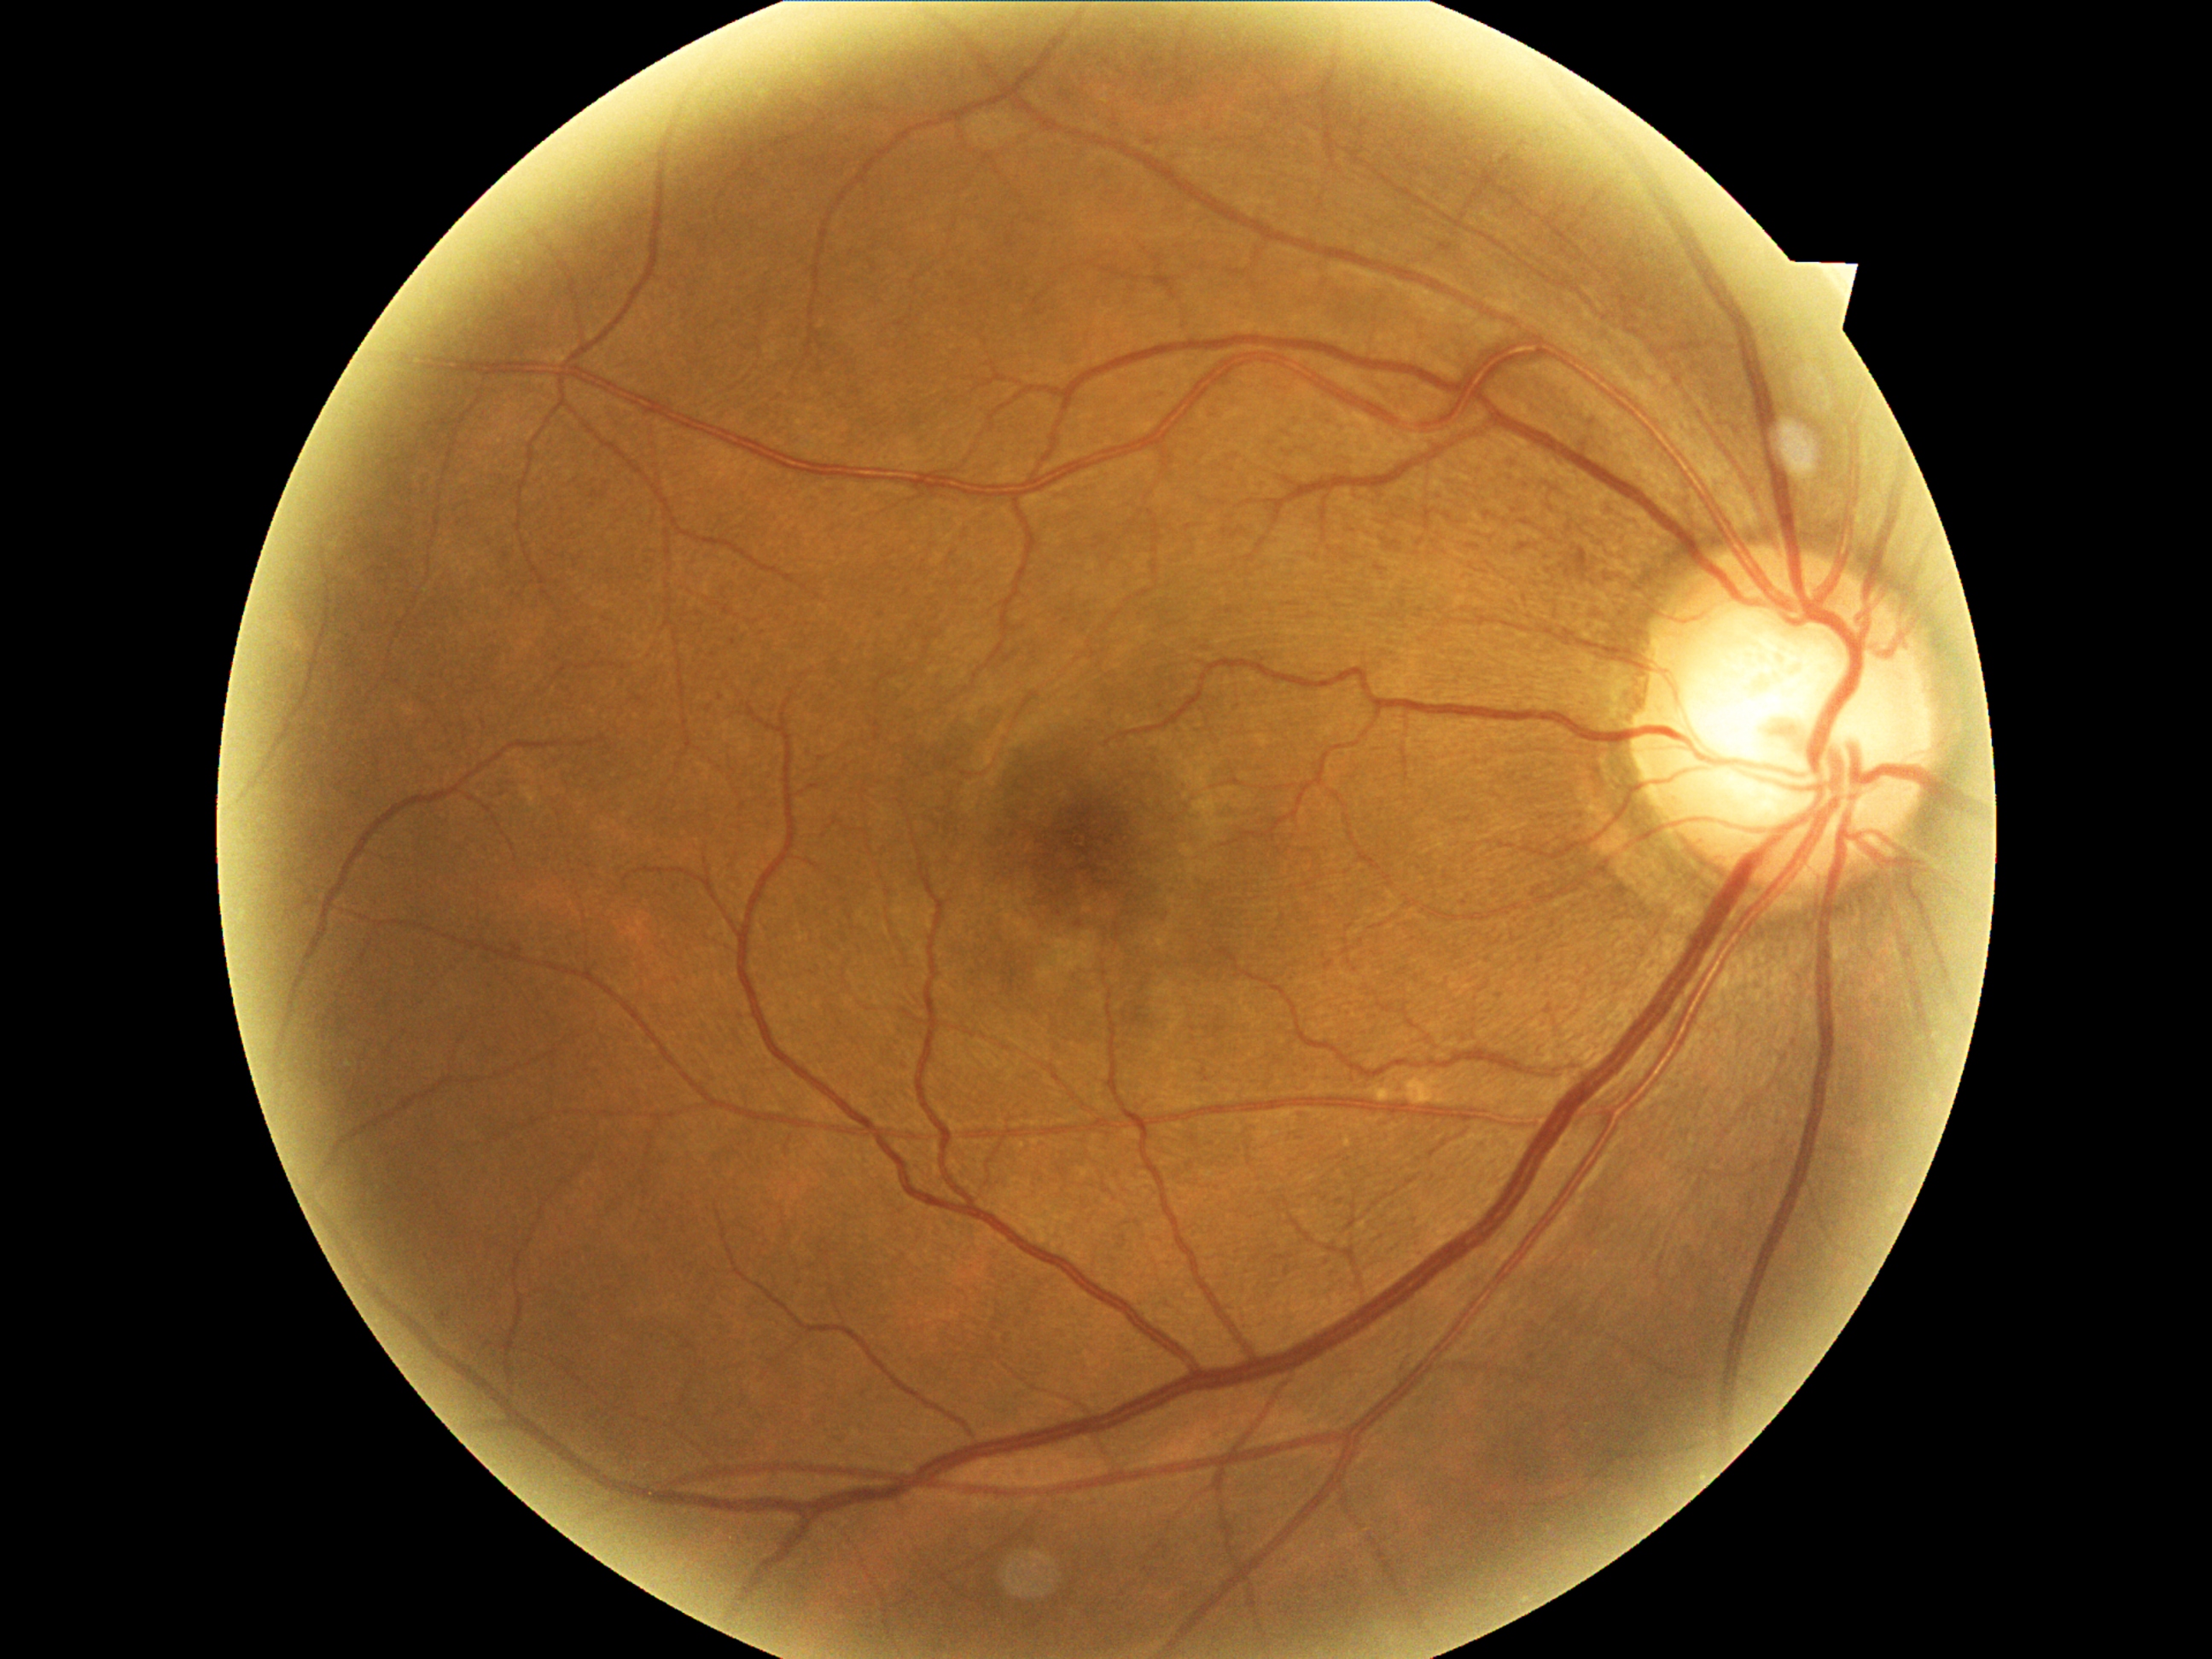 Findings:
* DR class: non-proliferative diabetic retinopathy
* DR grade: 1 — presence of microaneurysms only